Wide-field fundus photograph of an infant; 1240 by 1240 pixels: 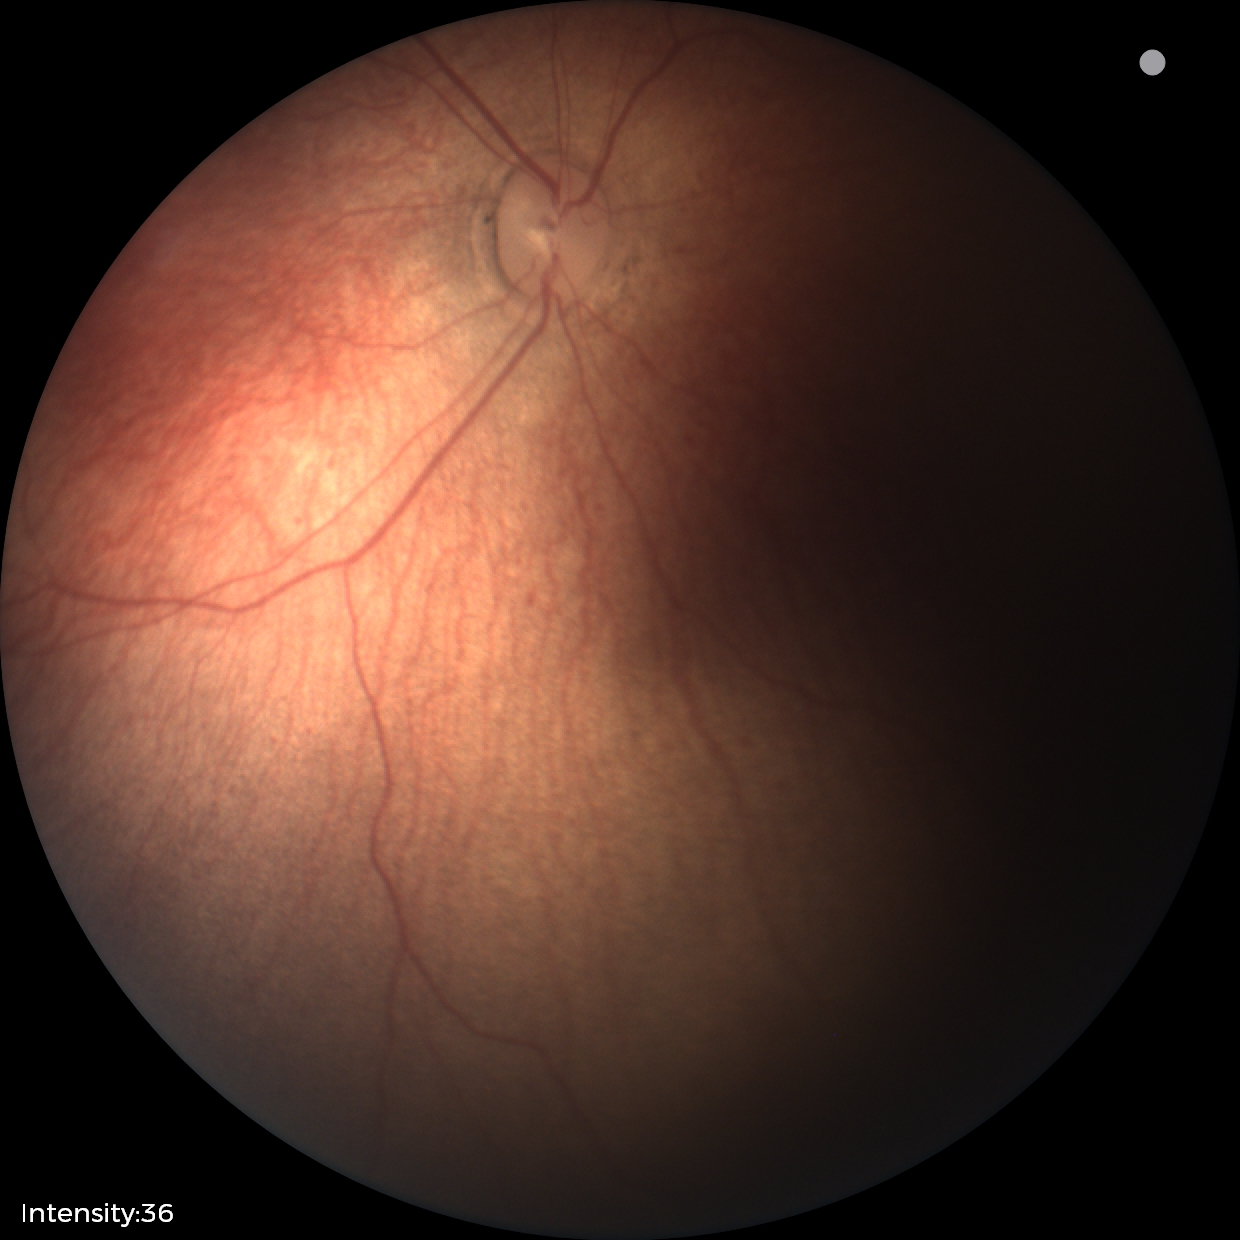 Screening examination with no abnormal retinal findings.